2212 by 1659 pixels, handheld portable fundus camera image — 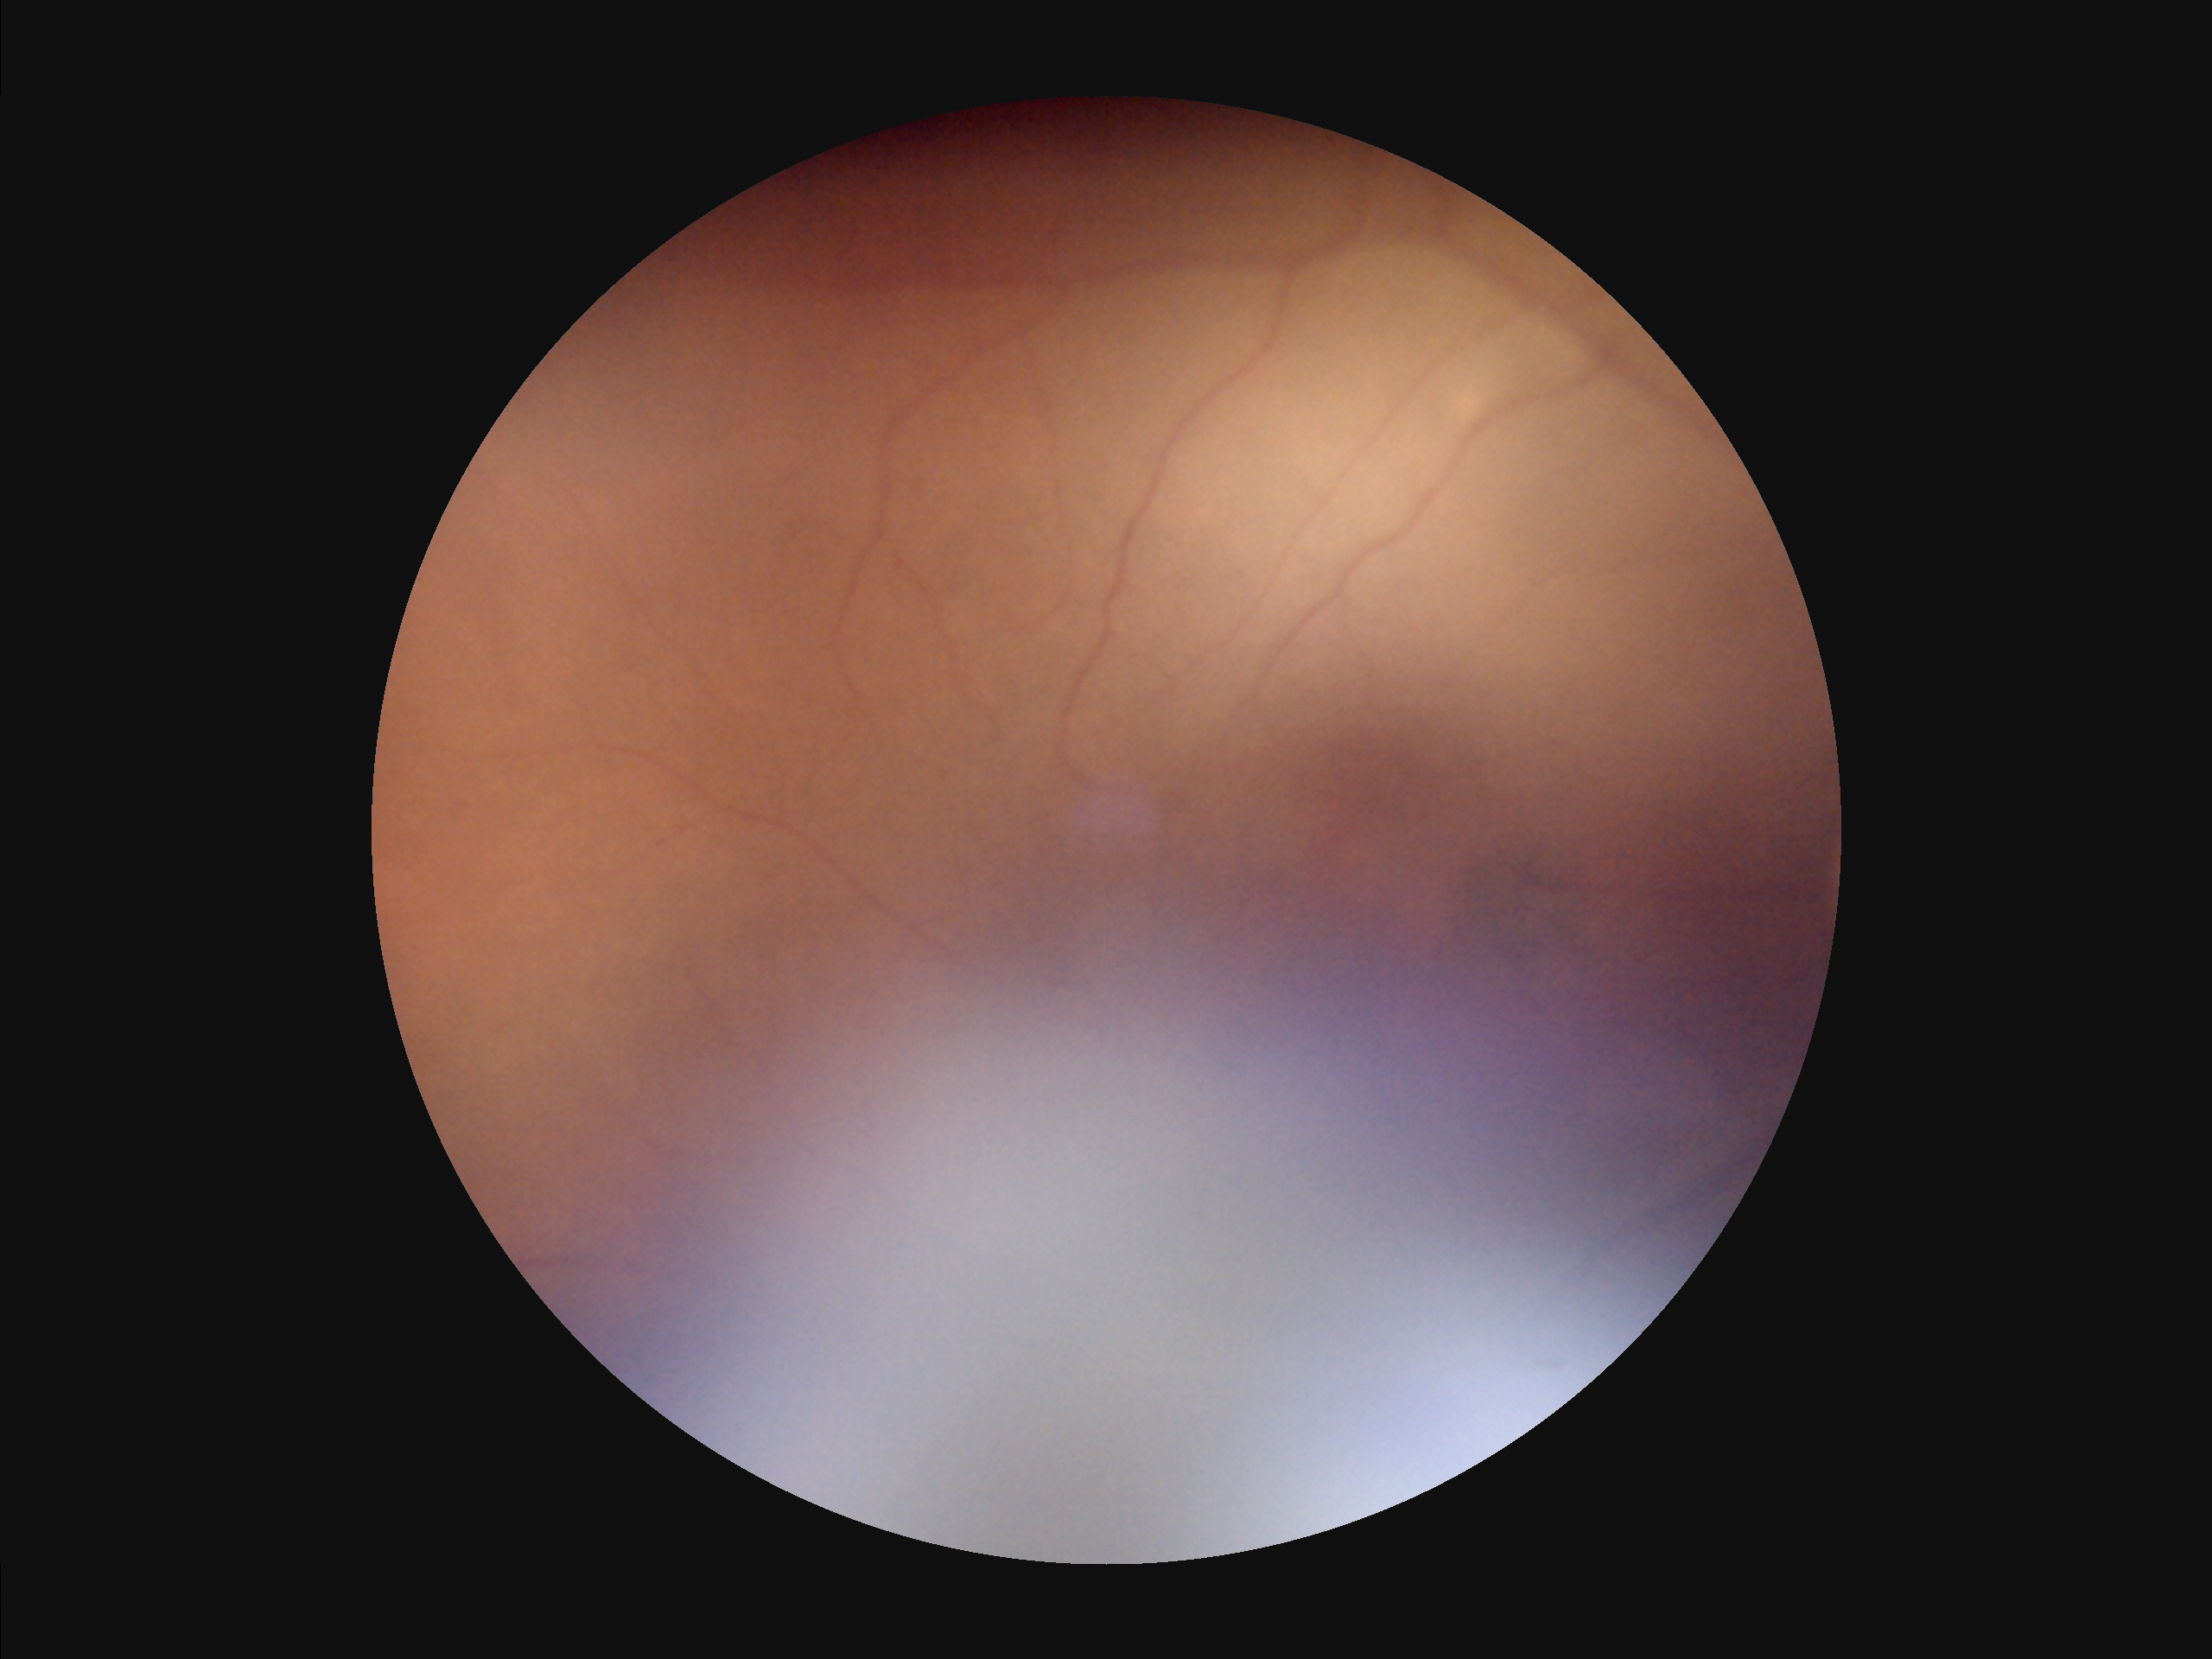 clarity: blurry
contrast: reduced
overall_quality: suboptimal
illumination: suboptimal